No pharmacologic dilation — 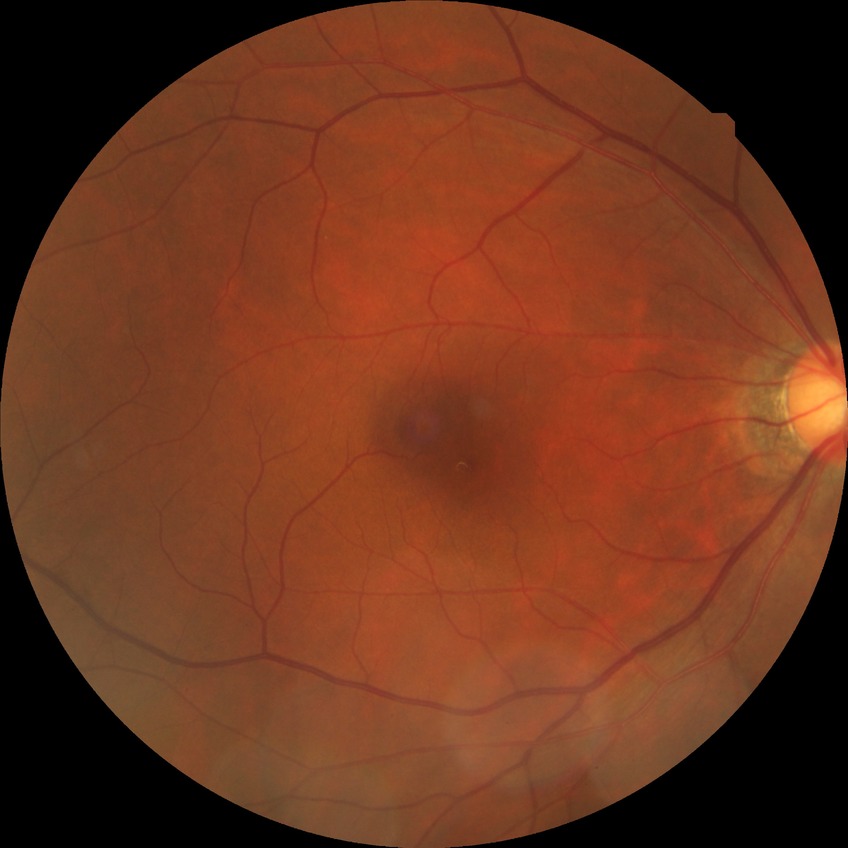

Retinopathy grade is no diabetic retinopathy.